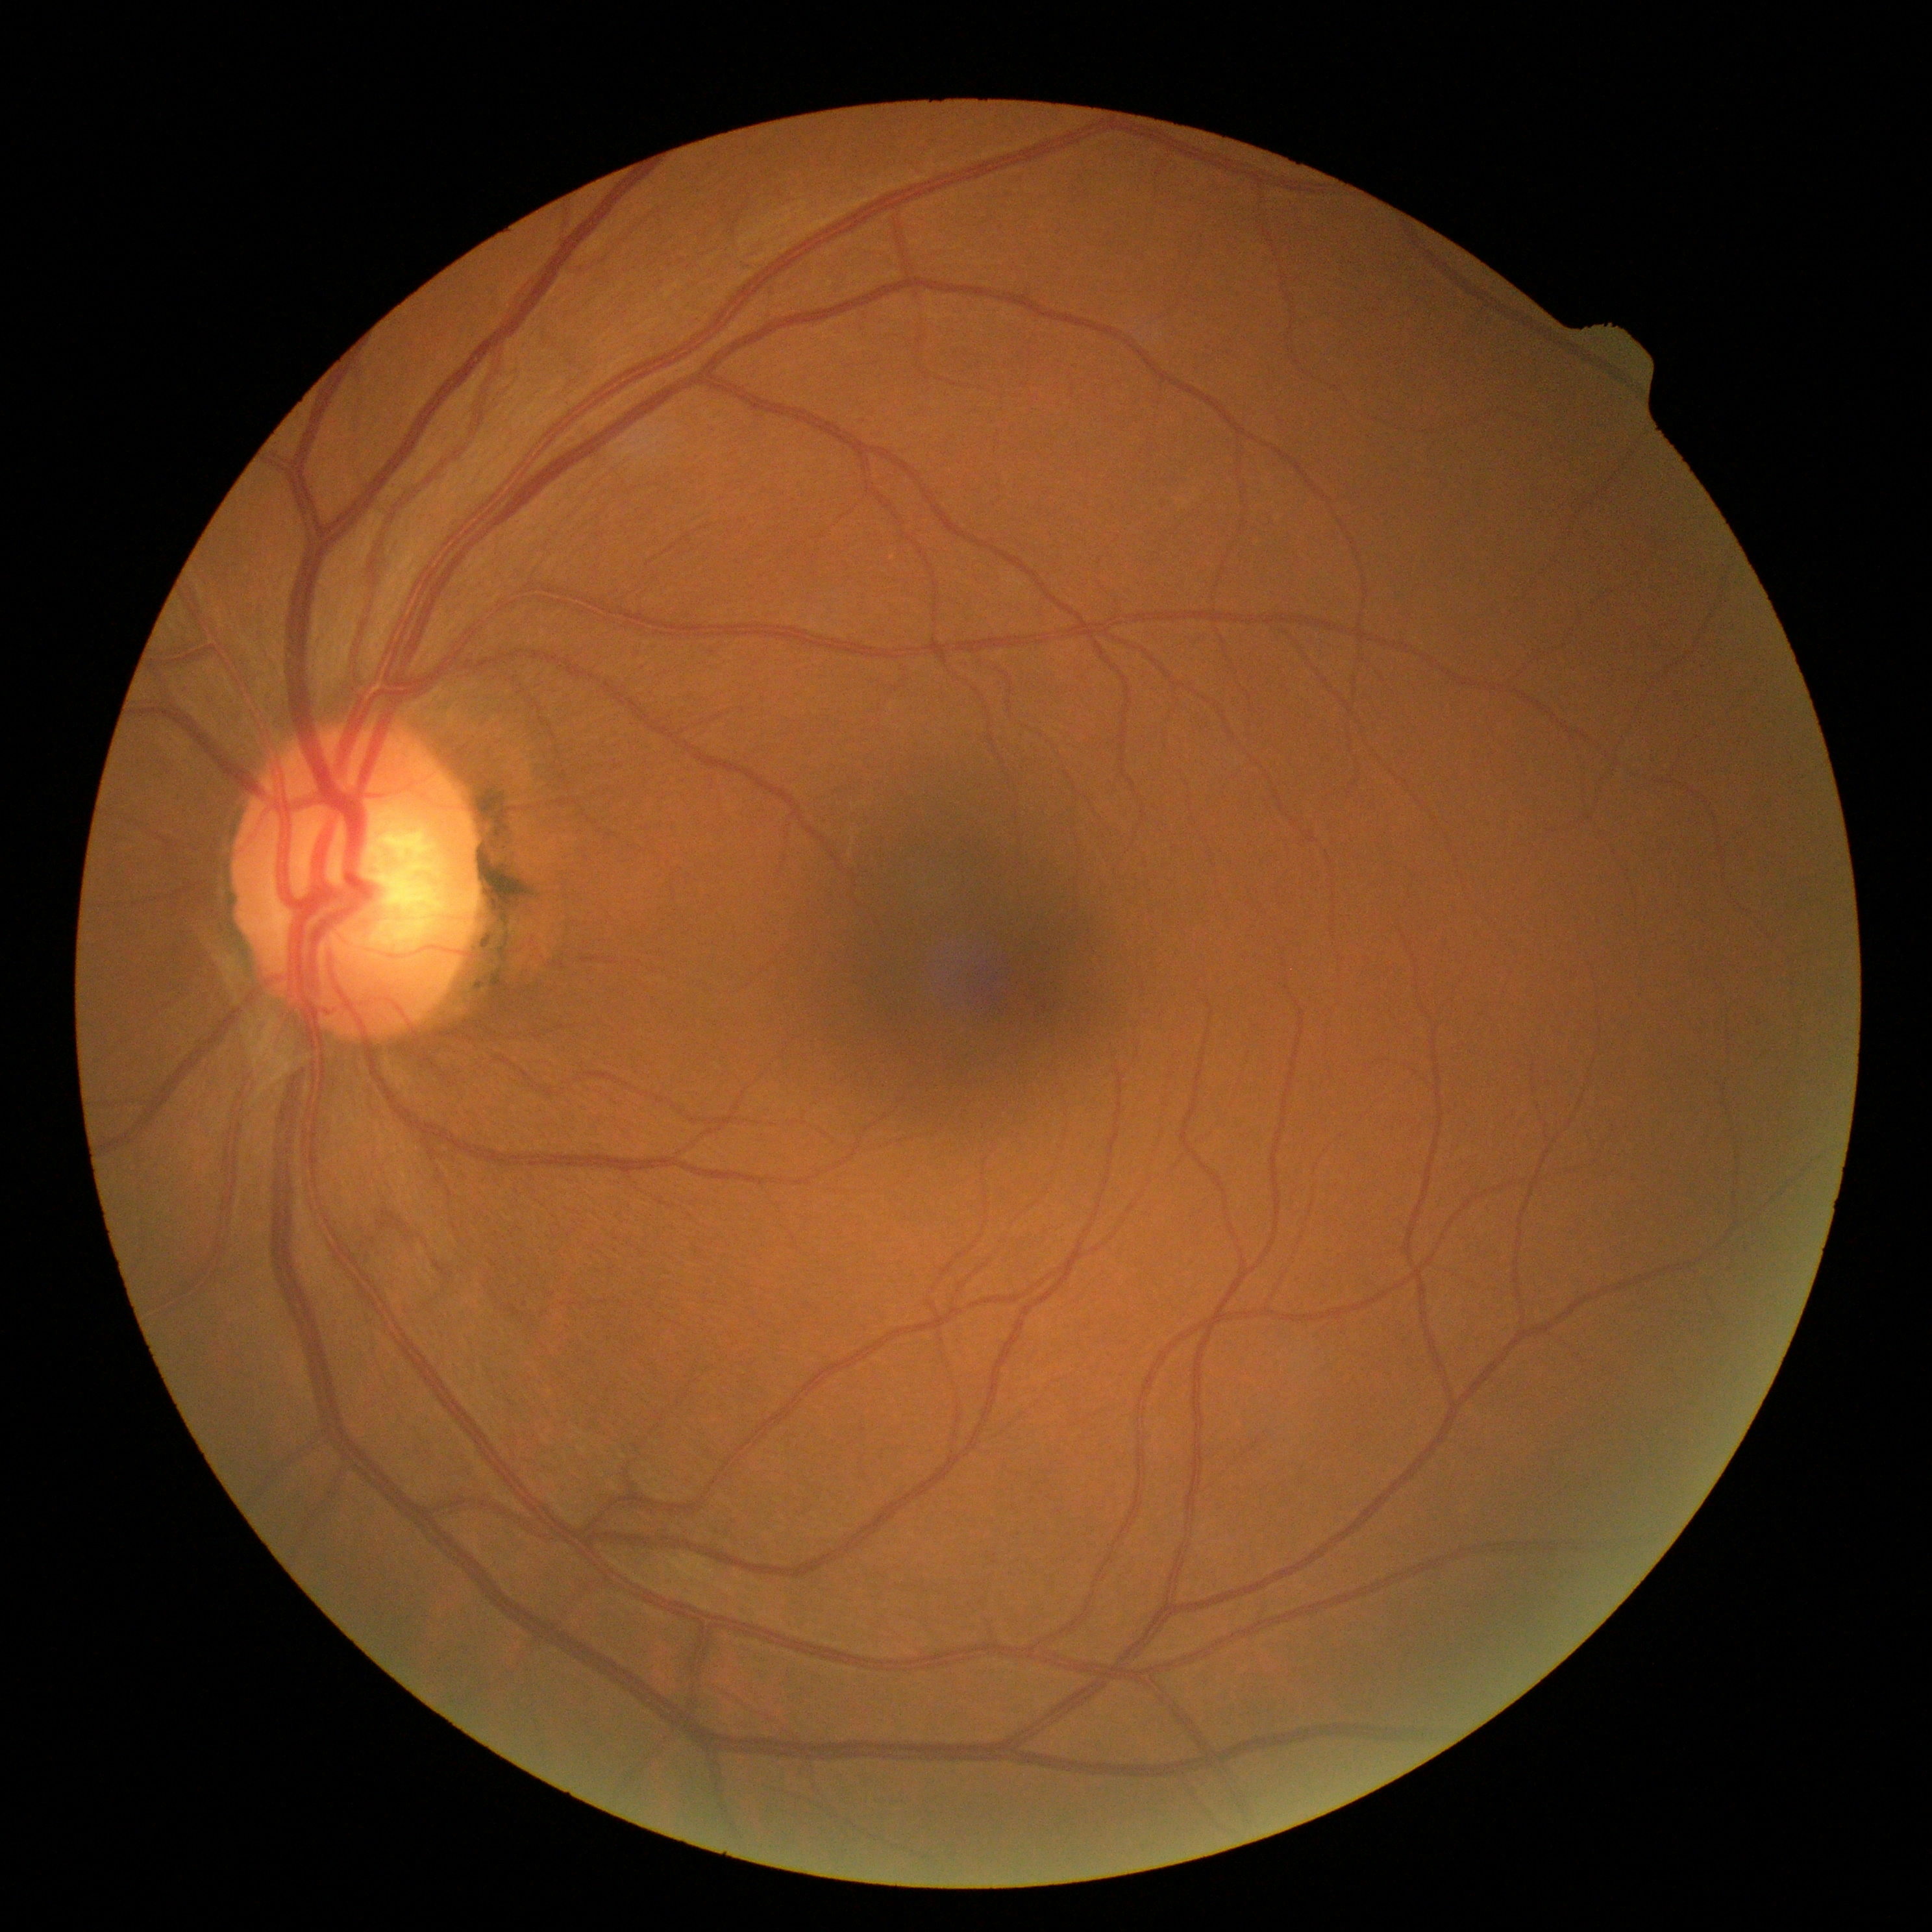
No DR findings. DR grade: 0 (no apparent retinopathy).